Ultra-widefield fundus mosaic:
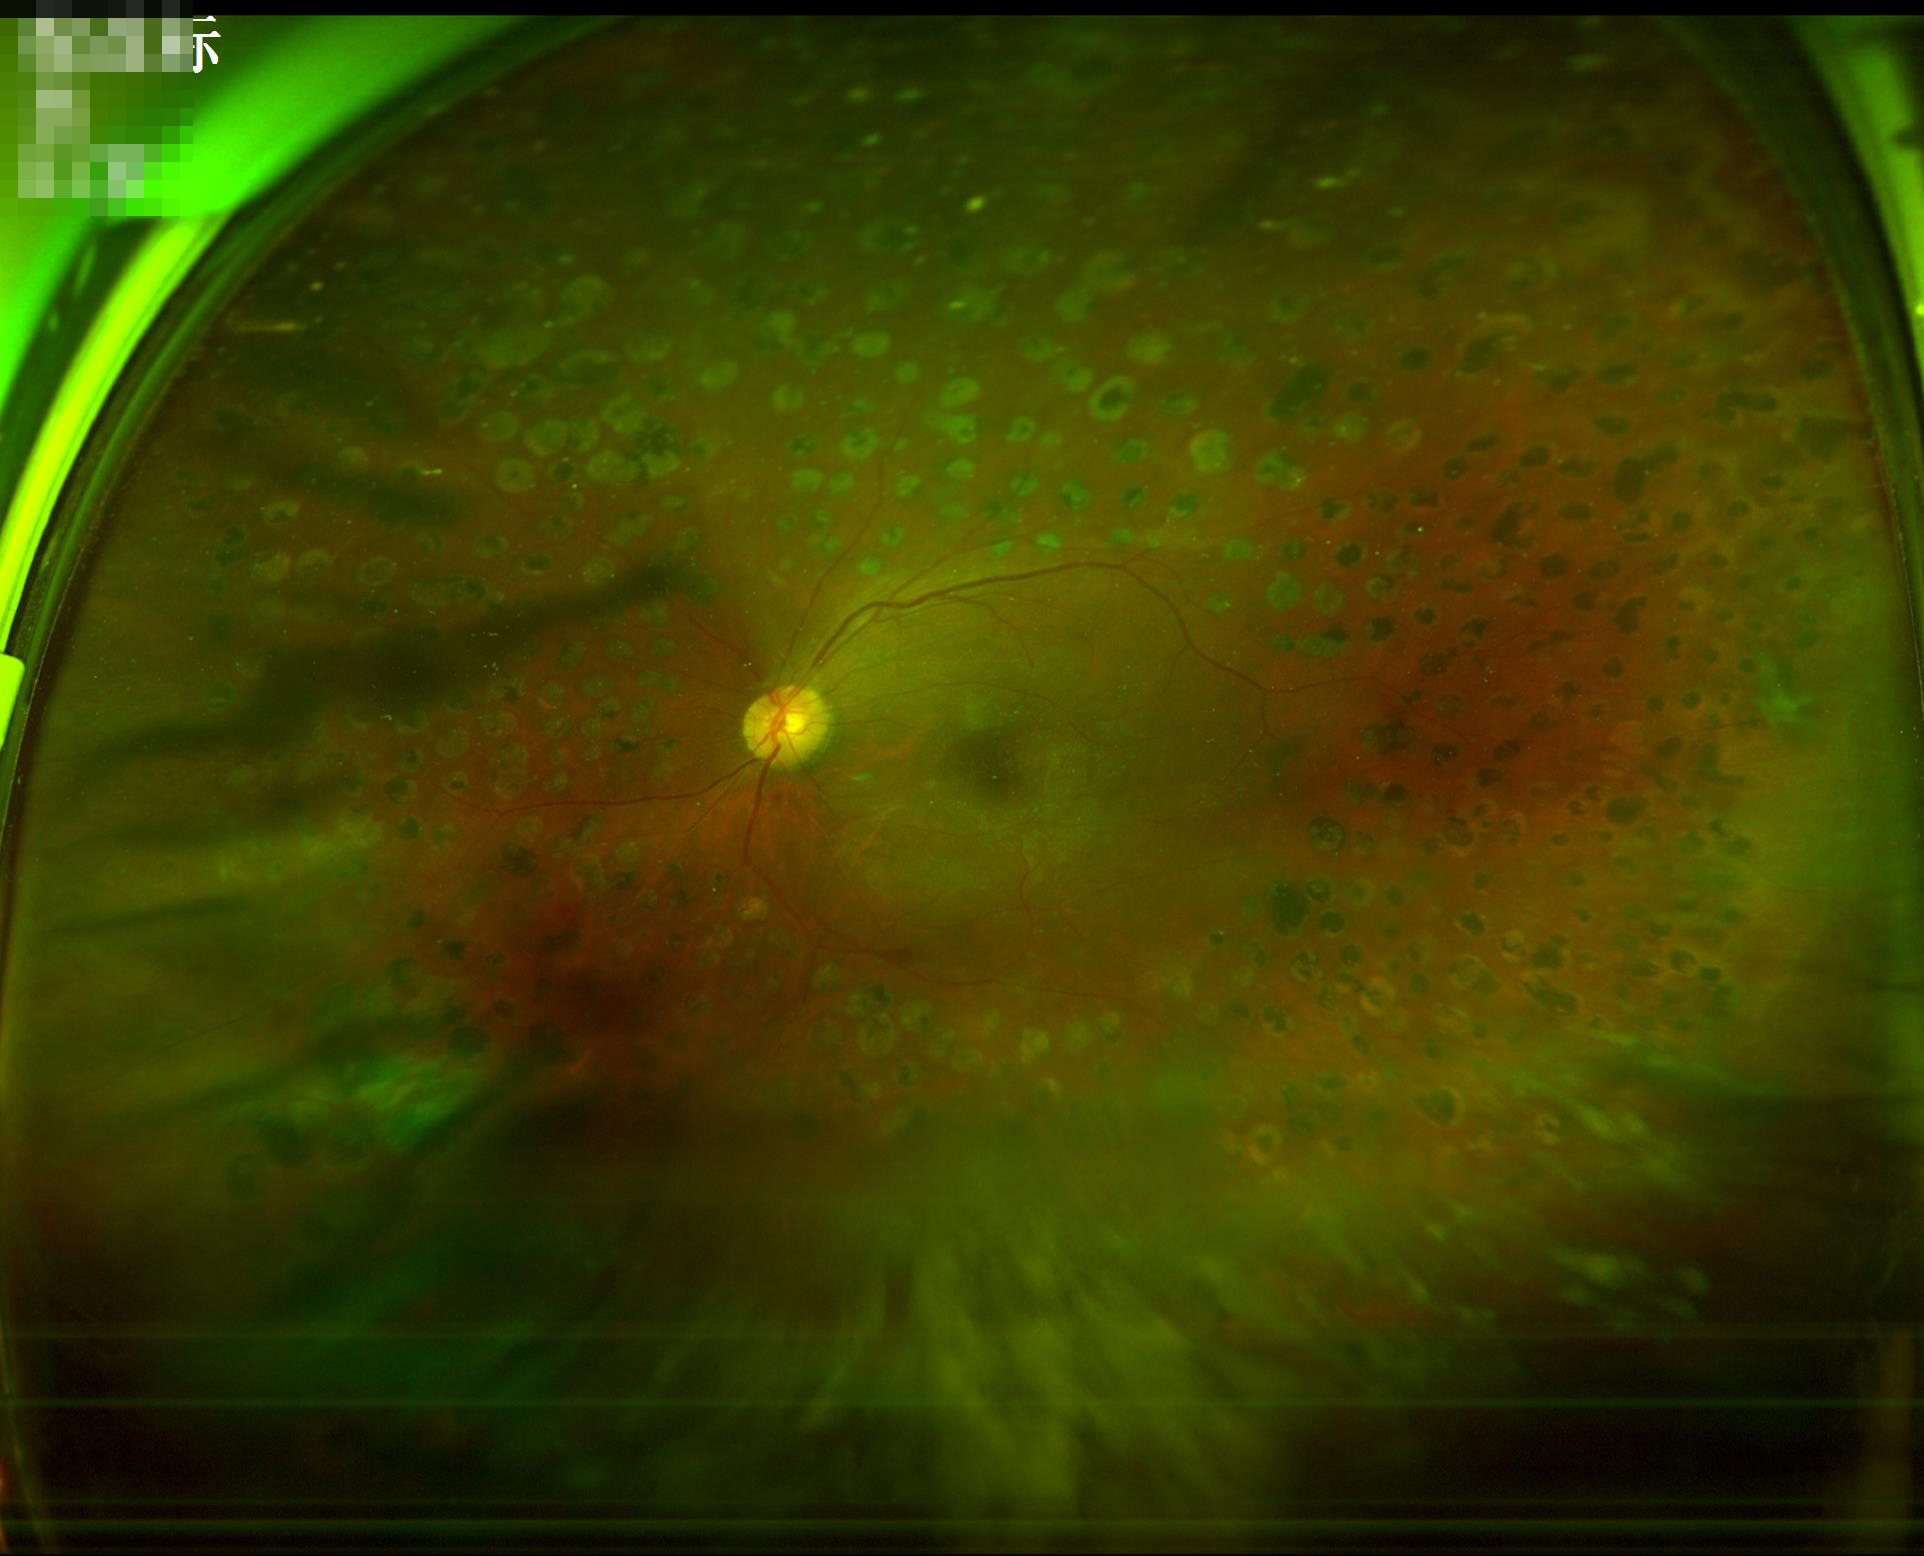

Noticeable blur in the optic disc, vessels, or background.
Overall quality is poor; the image is difficult to grade.
There is over- or under-exposure or a color cast.
Contrast is good.